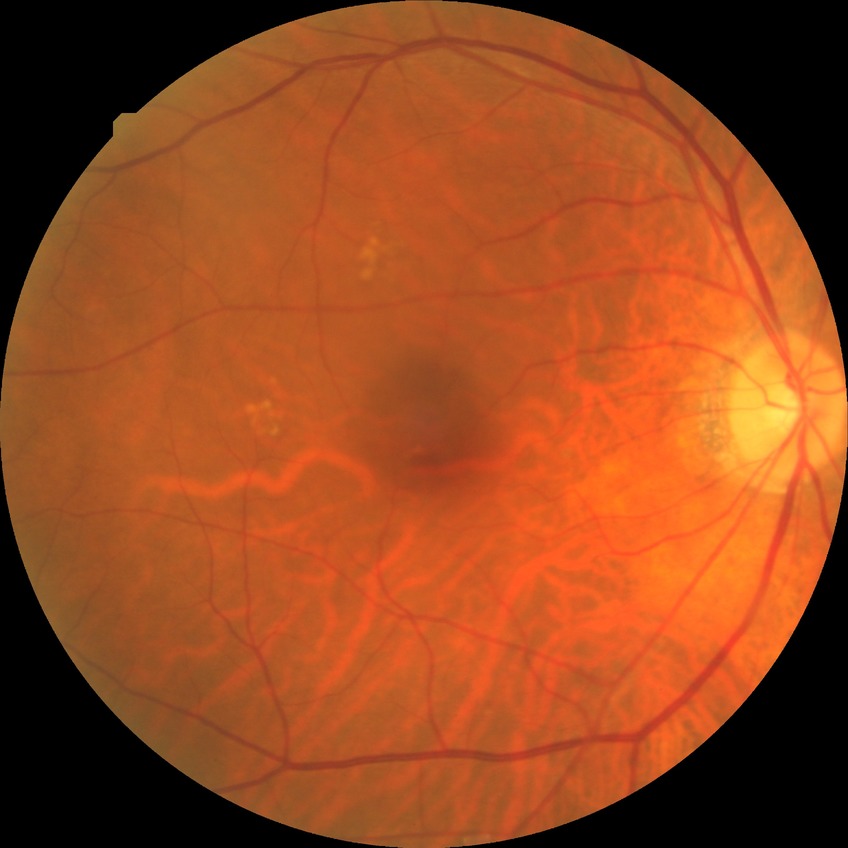
{
  "davis_grade": "no diabetic retinopathy"
}